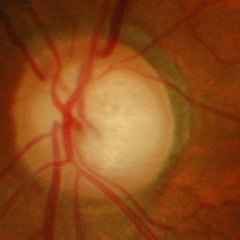
Glaucoma is present. Diagnosis: advanced glaucoma.